Wide-field fundus image from infant ROP screening.
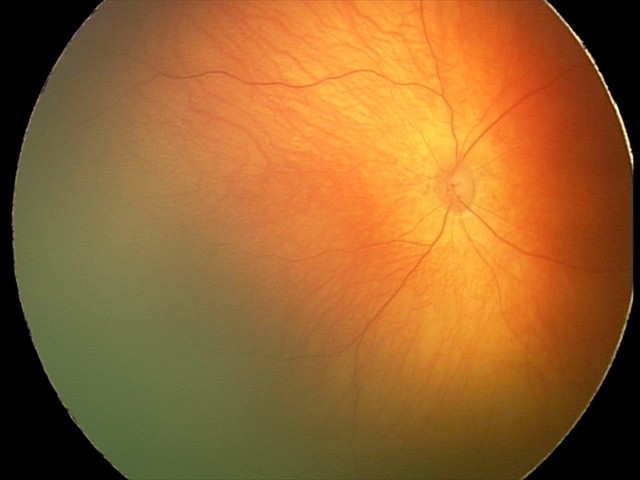

Assessment: physiological appearance.